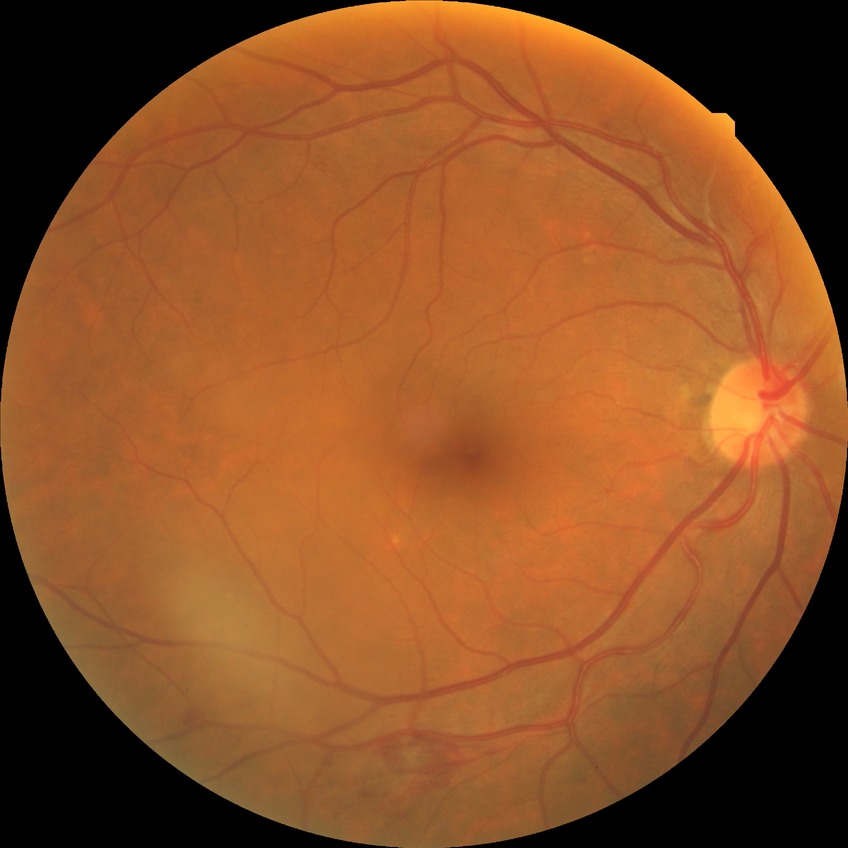 The retinopathy is classified as non-proliferative diabetic retinopathy. Diabetic retinopathy (DR) is simple diabetic retinopathy (SDR).